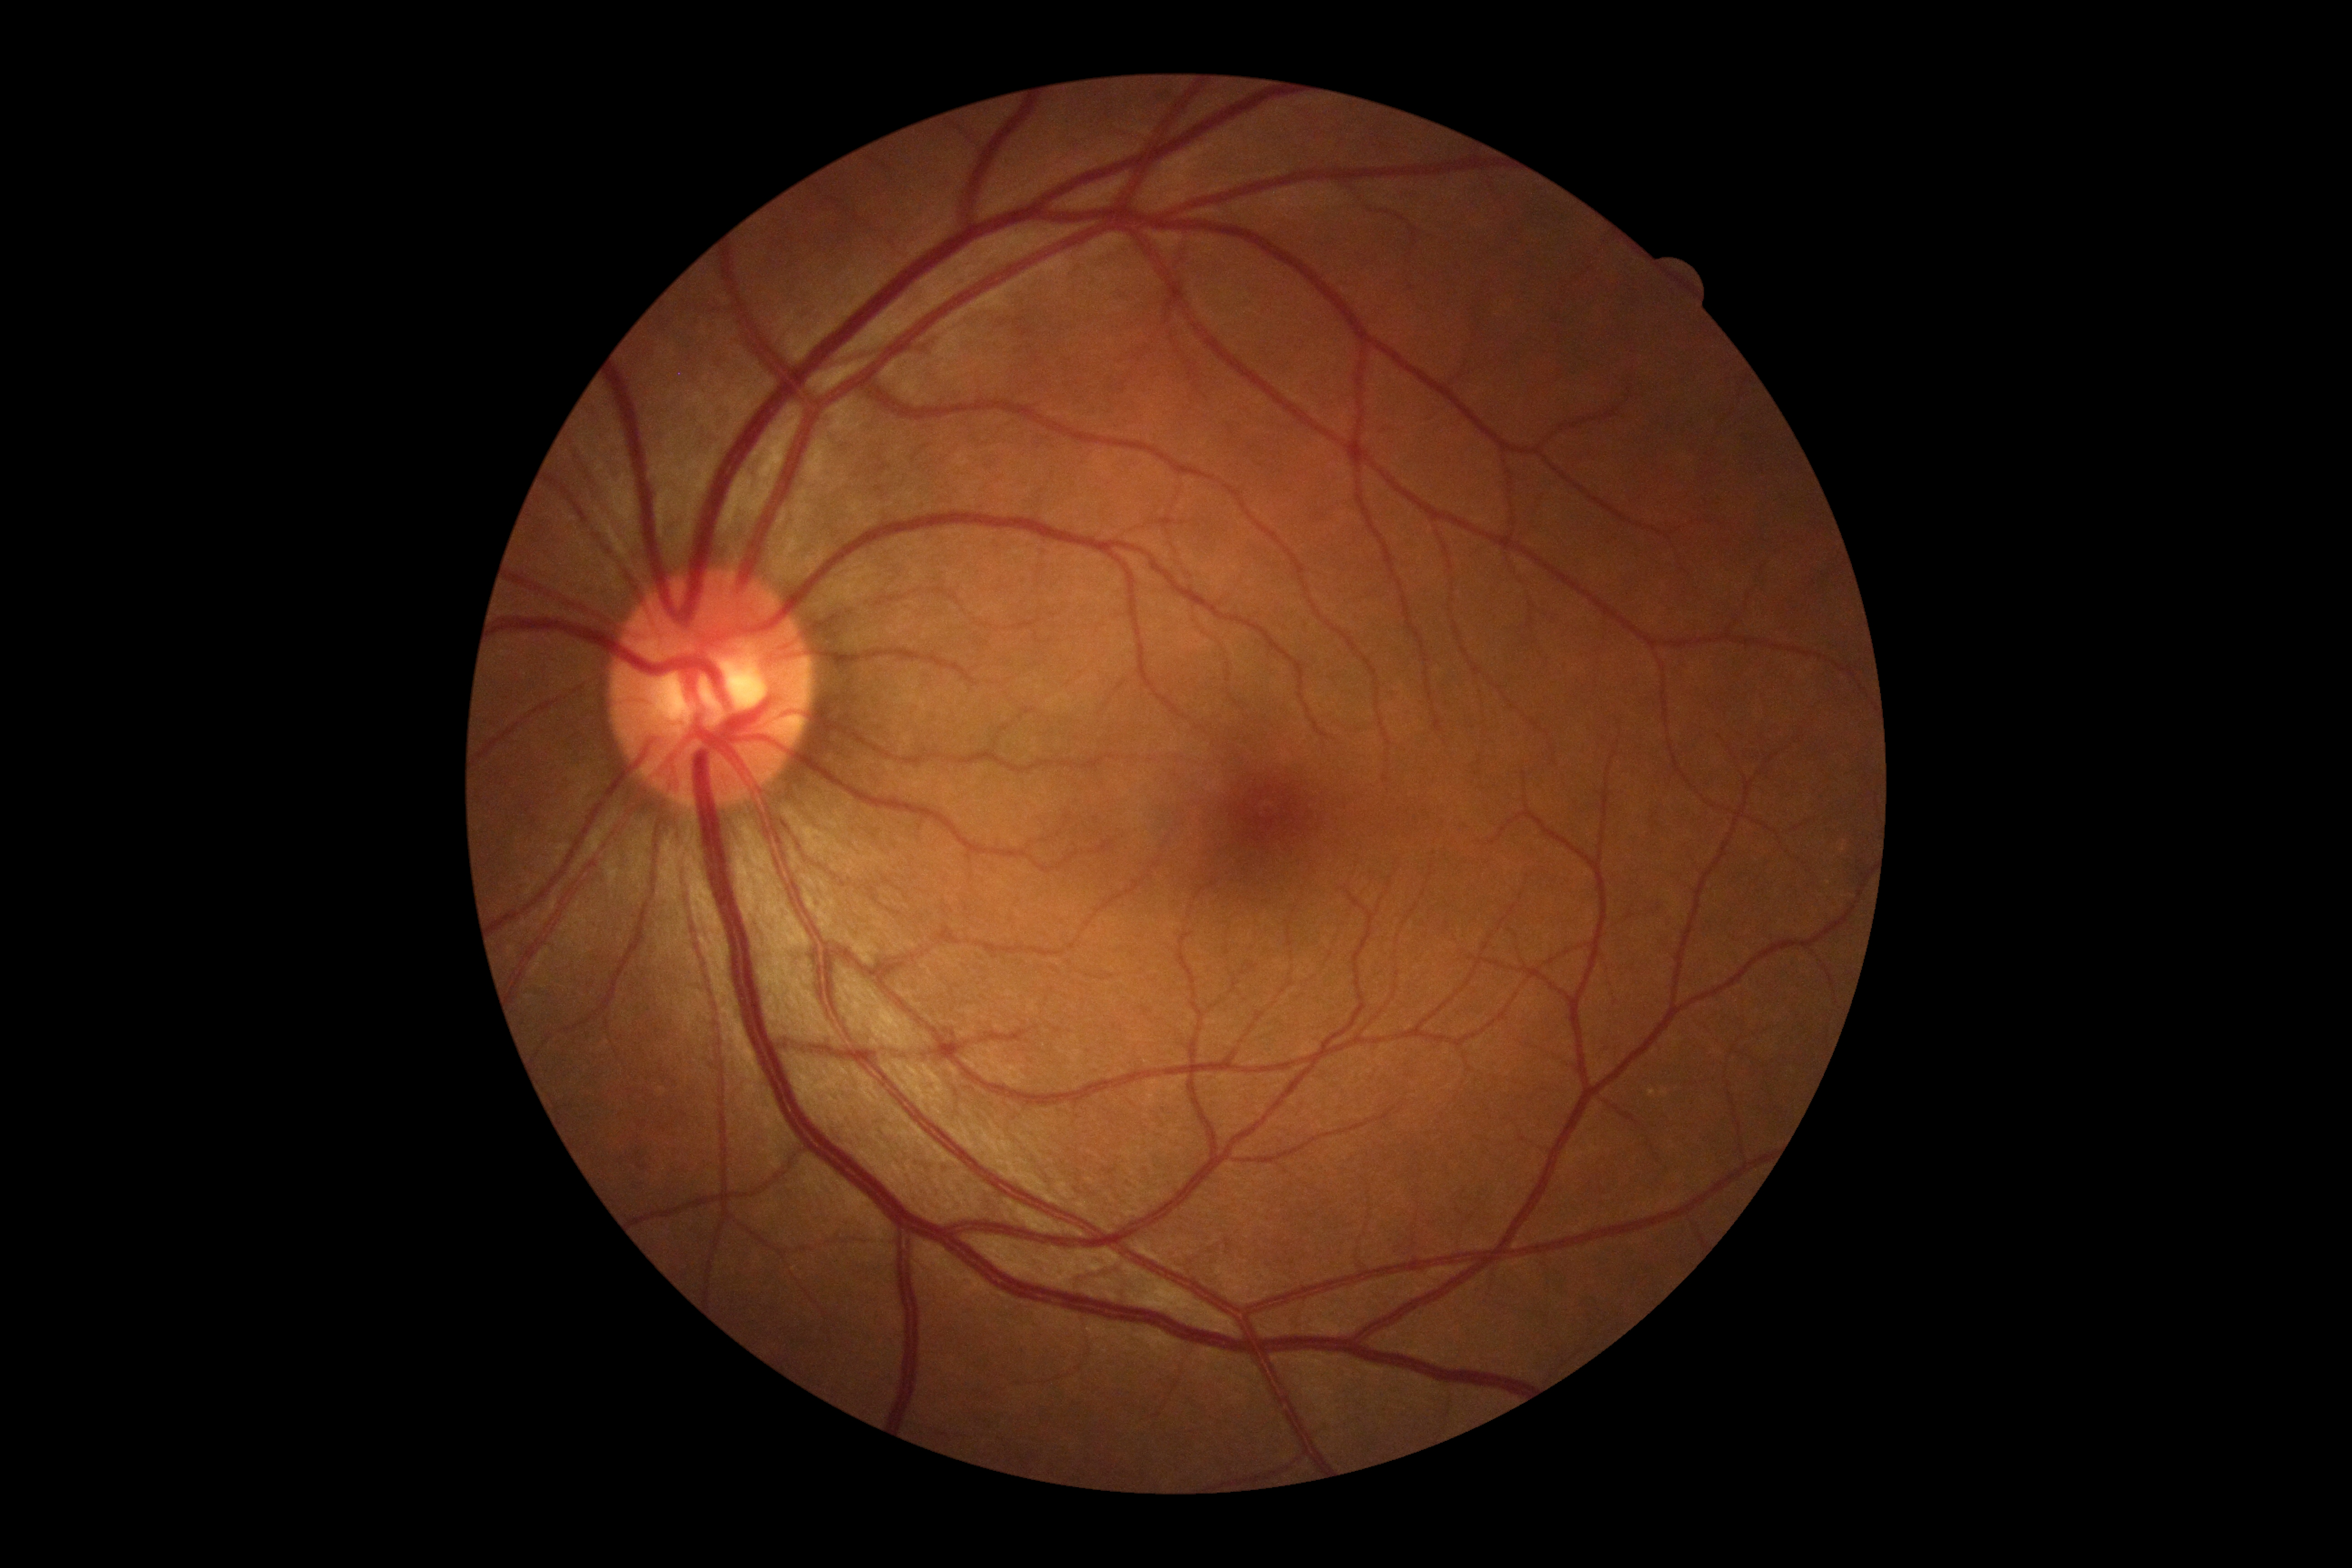

{
  "dr_grade": "no apparent diabetic retinopathy (grade 0) — no visible signs of diabetic retinopathy"
}